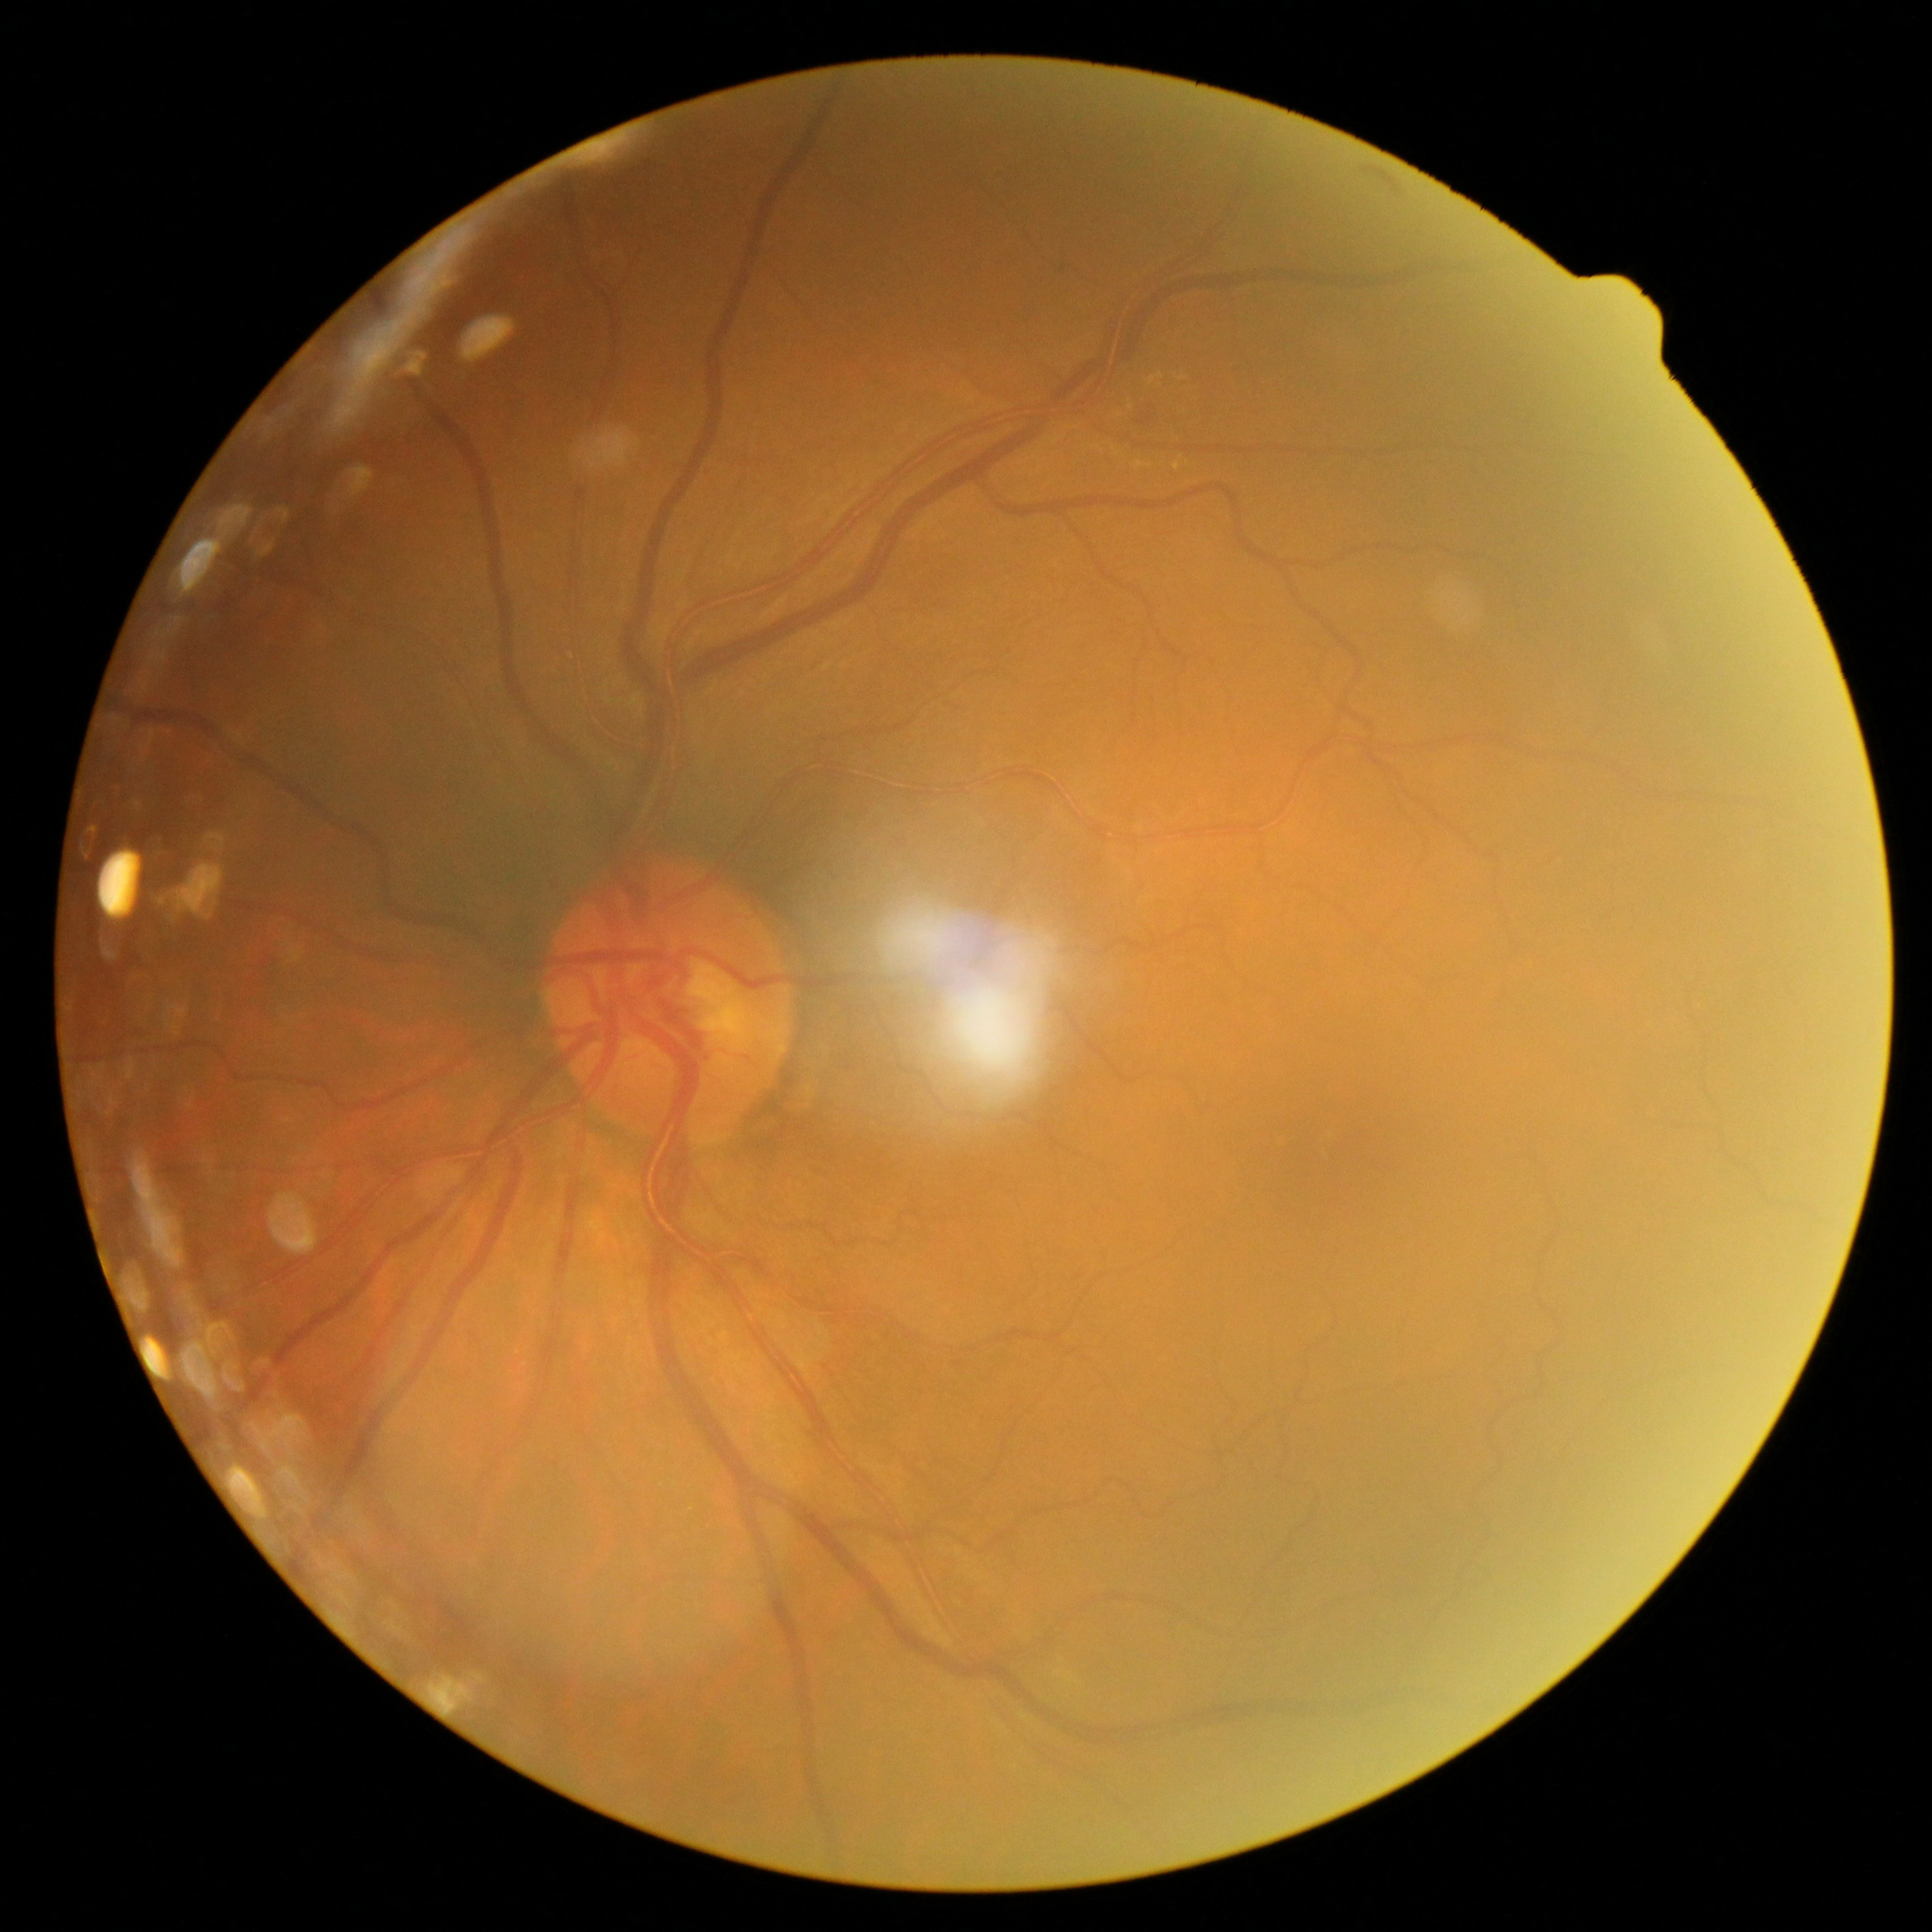
Diabetic retinopathy severity: 2/4.